Nonmydriatic; DR severity per modified Davis staging
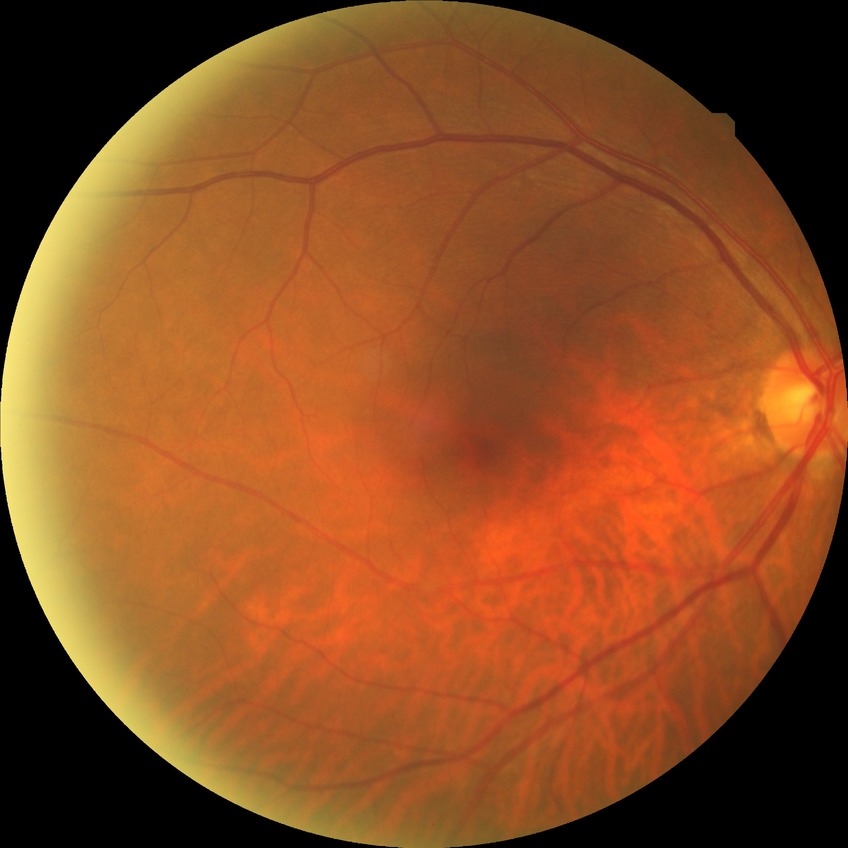

{
  "davis_grade": "no diabetic retinopathy"
}